FOV: 45 degrees · 848x848px · NIDEK AFC-230 · color fundus photograph
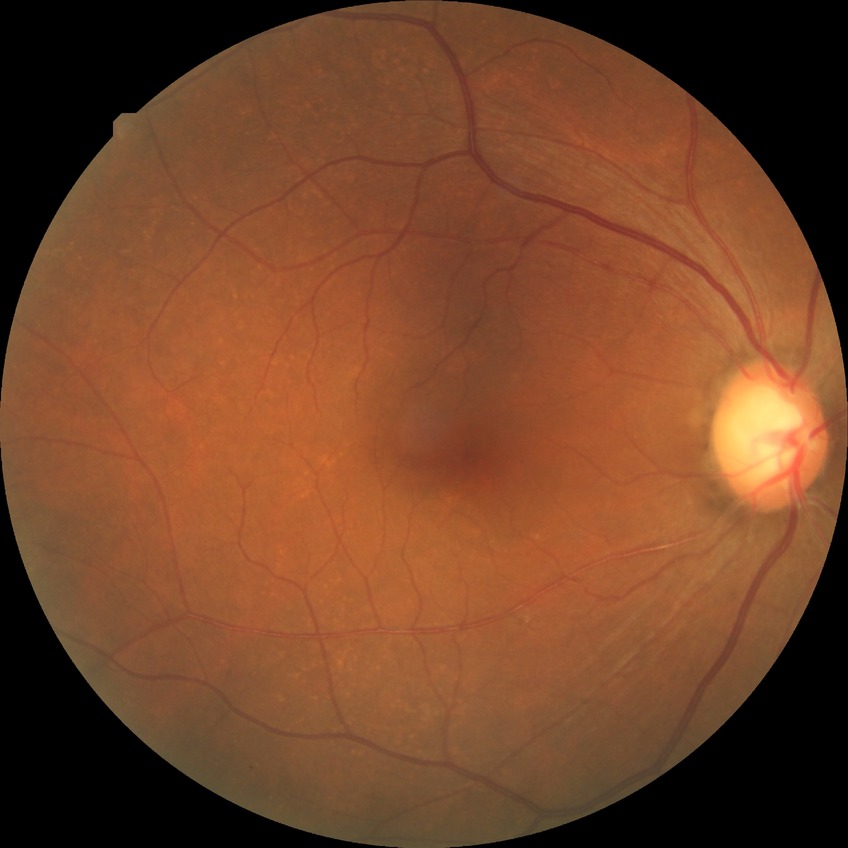
retinopathy stage = no diabetic retinopathy.